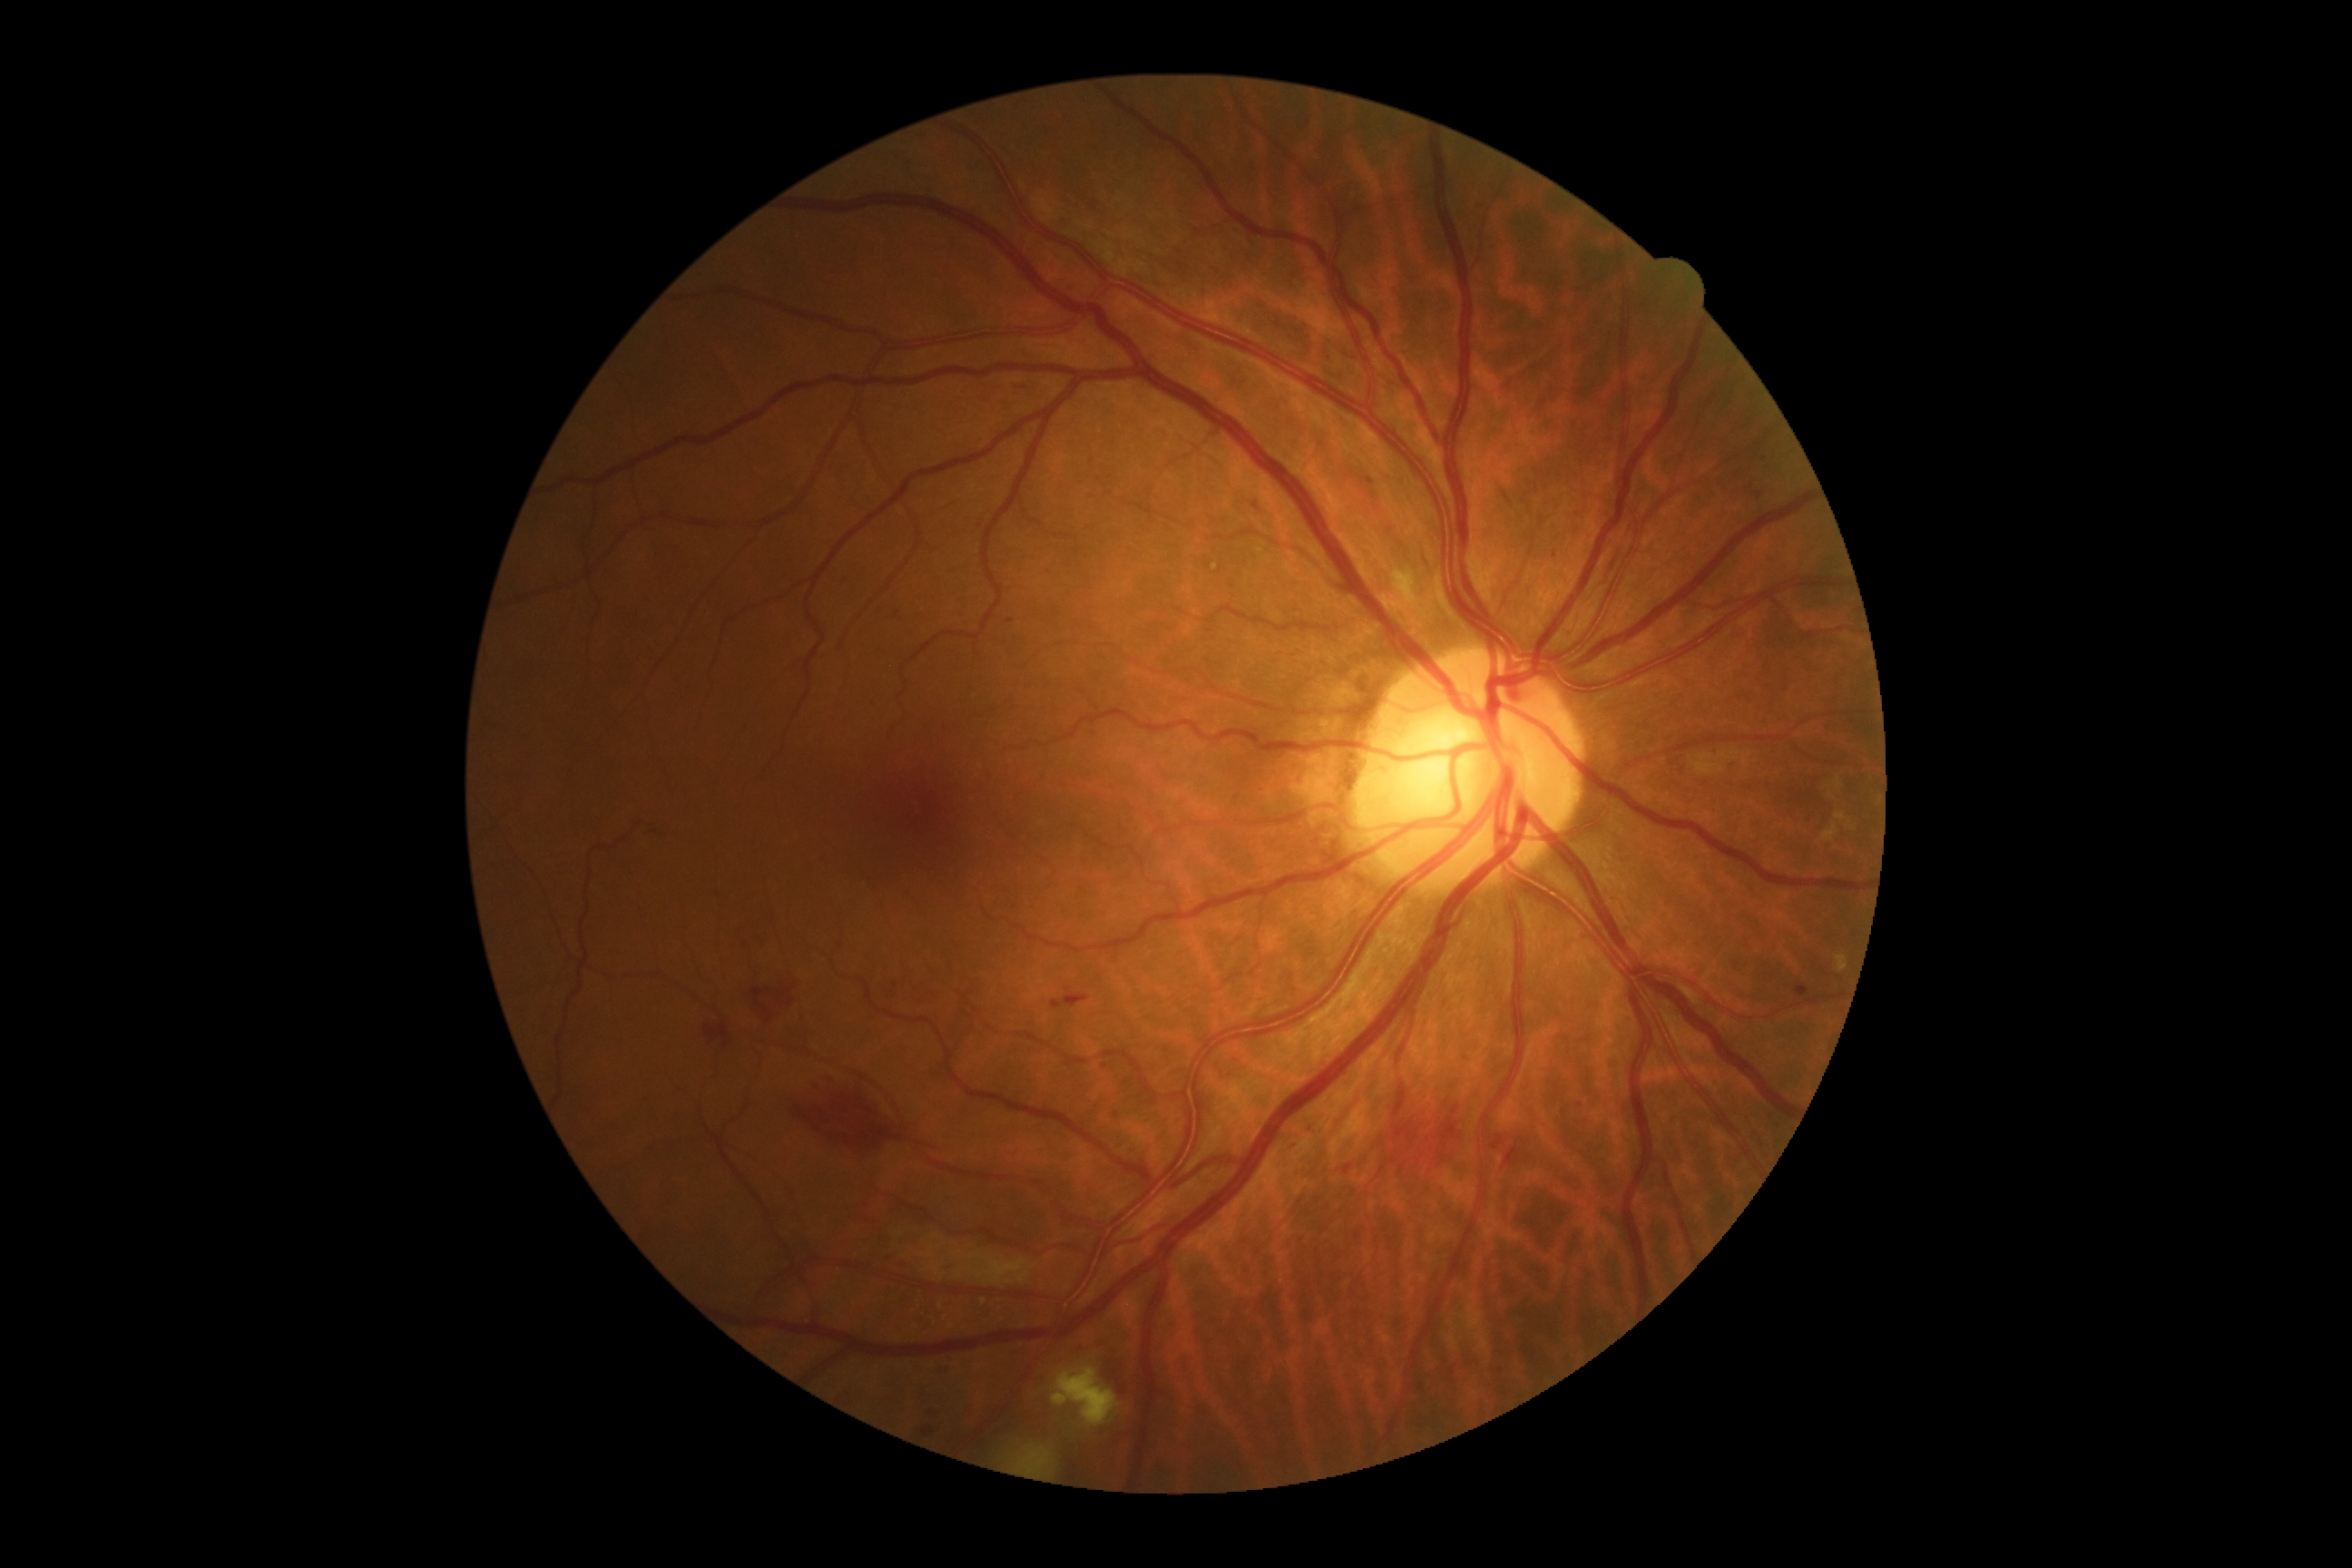 Diabetic retinopathy: moderate non-proliferative diabetic retinopathy (grade 2) — more than just microaneurysms but less than severe NPDR.